Fundus photo: 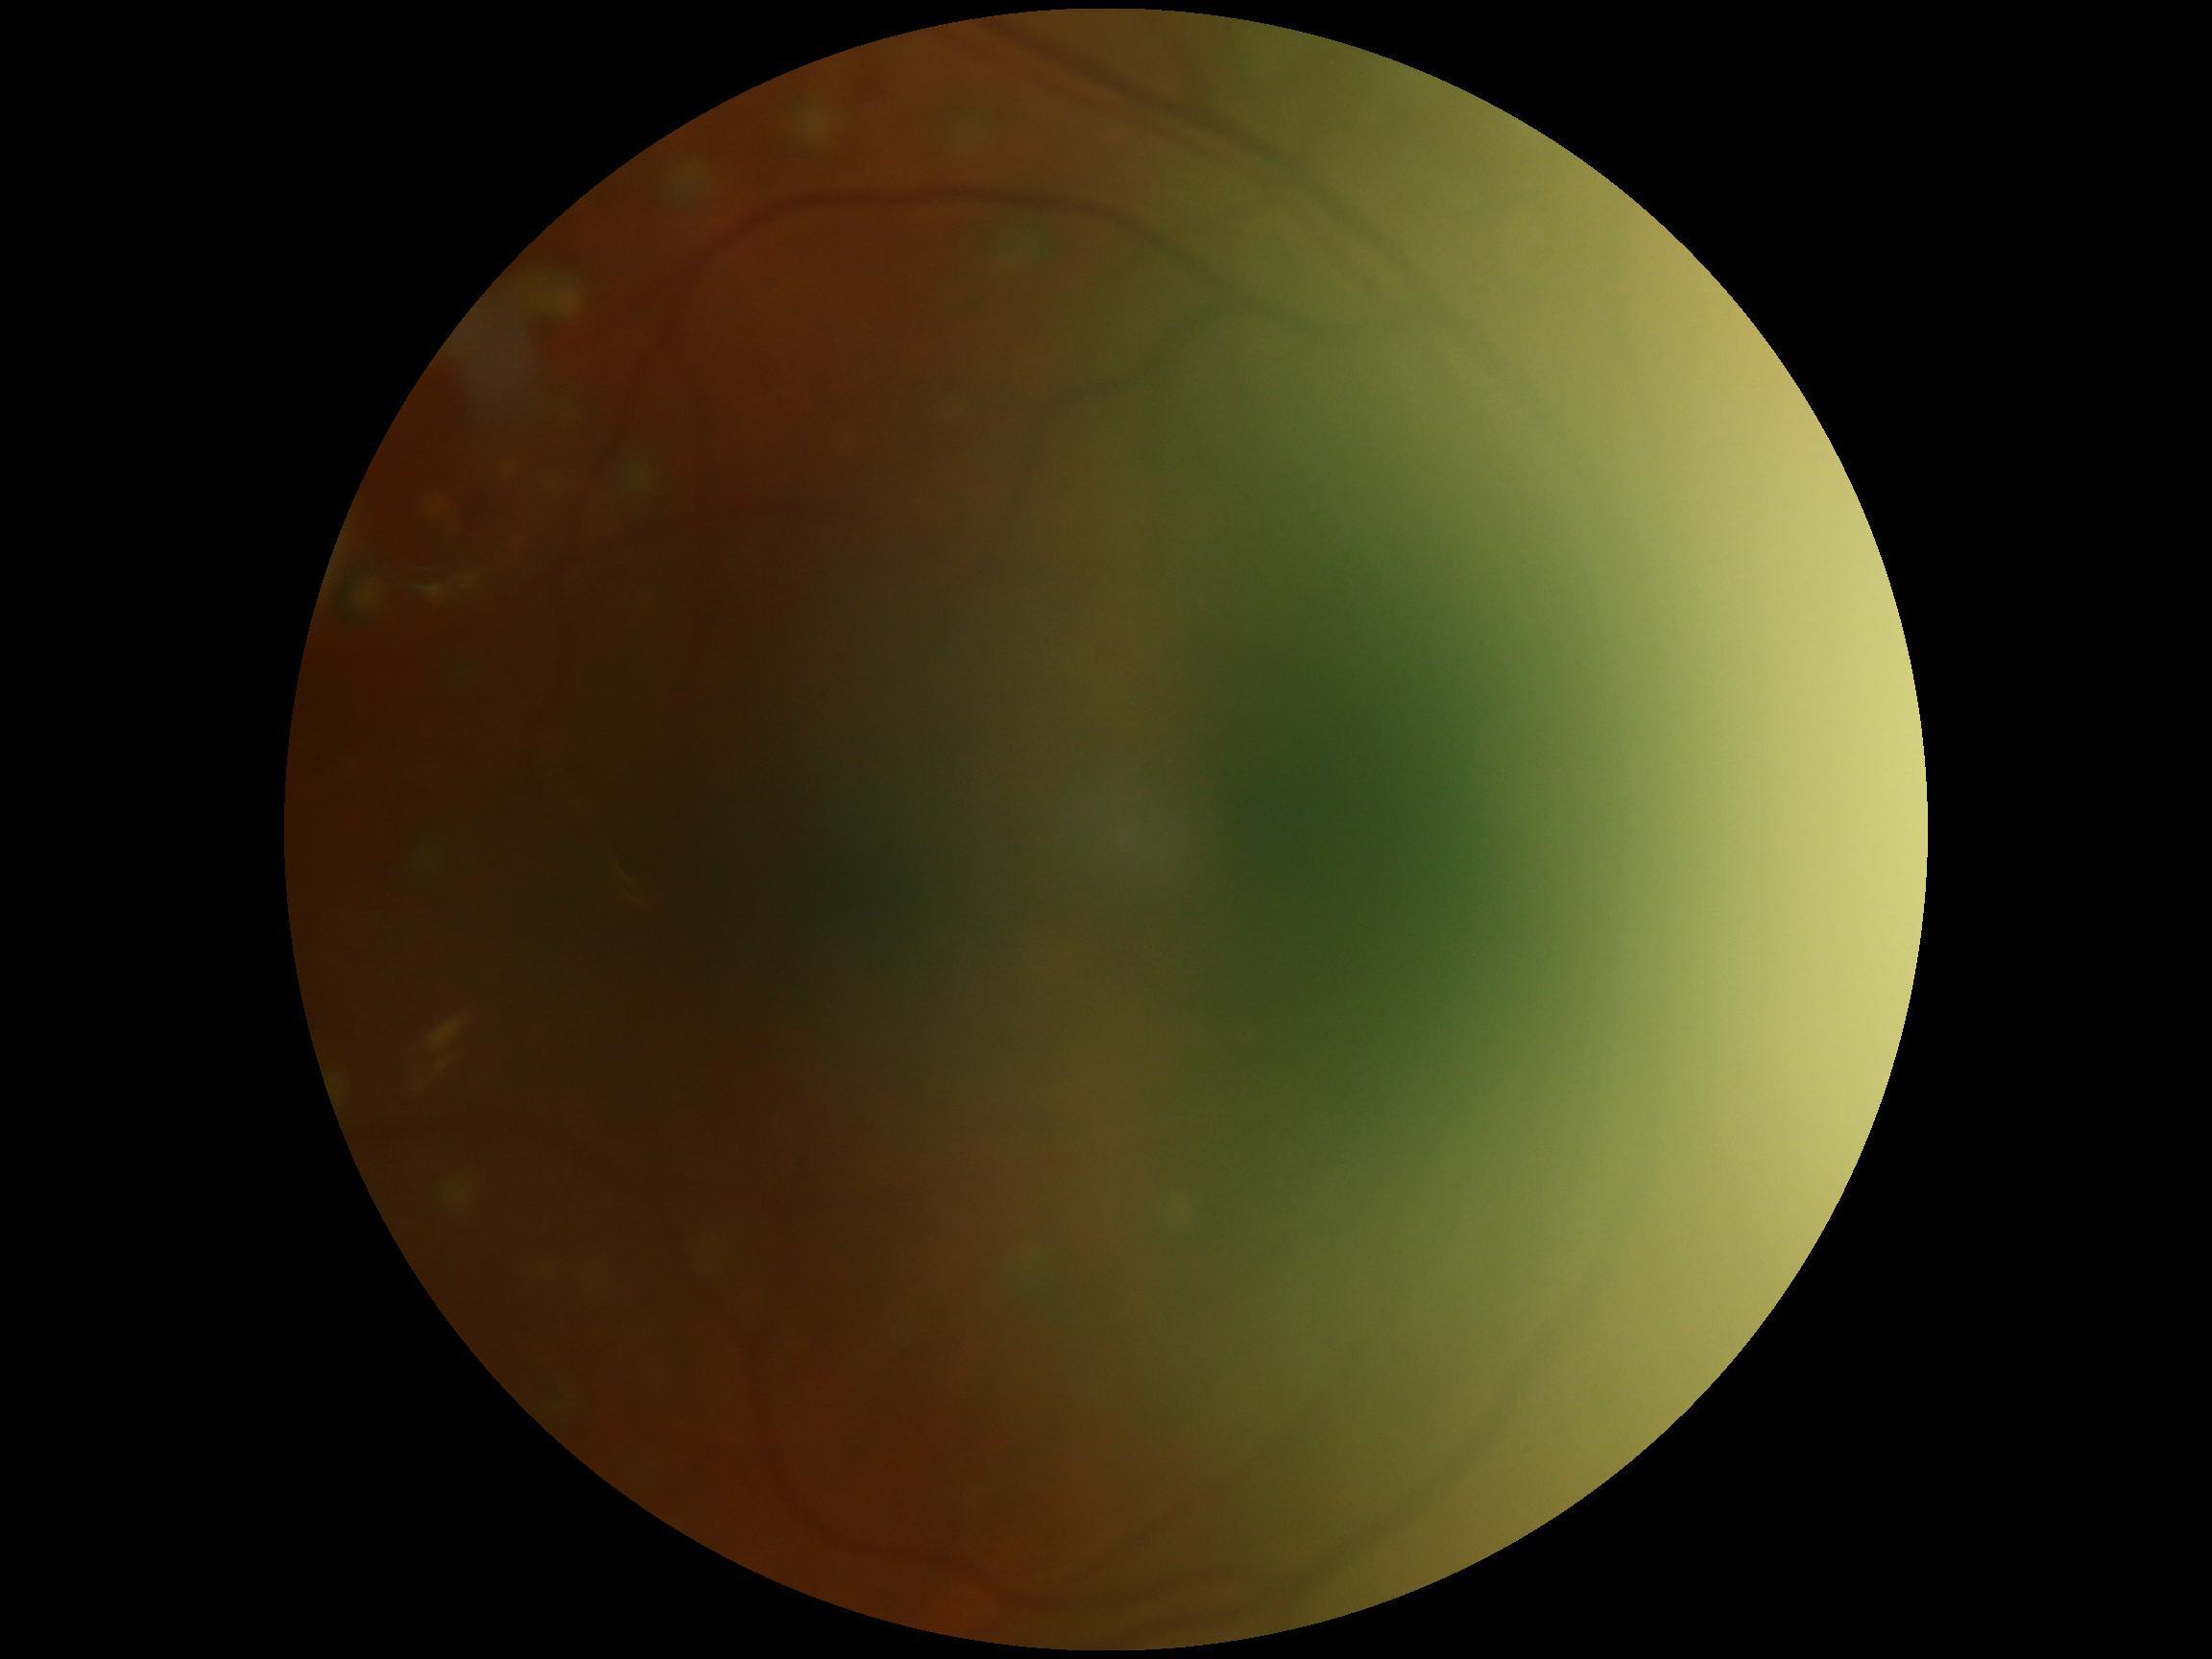

Ungradable image — DR severity cannot be determined. Diabetic retinopathy is ungradable due to poor image quality.